CFP; nonmydriatic fundus photograph; camera: NIDEK AFC-230; 45° FOV: 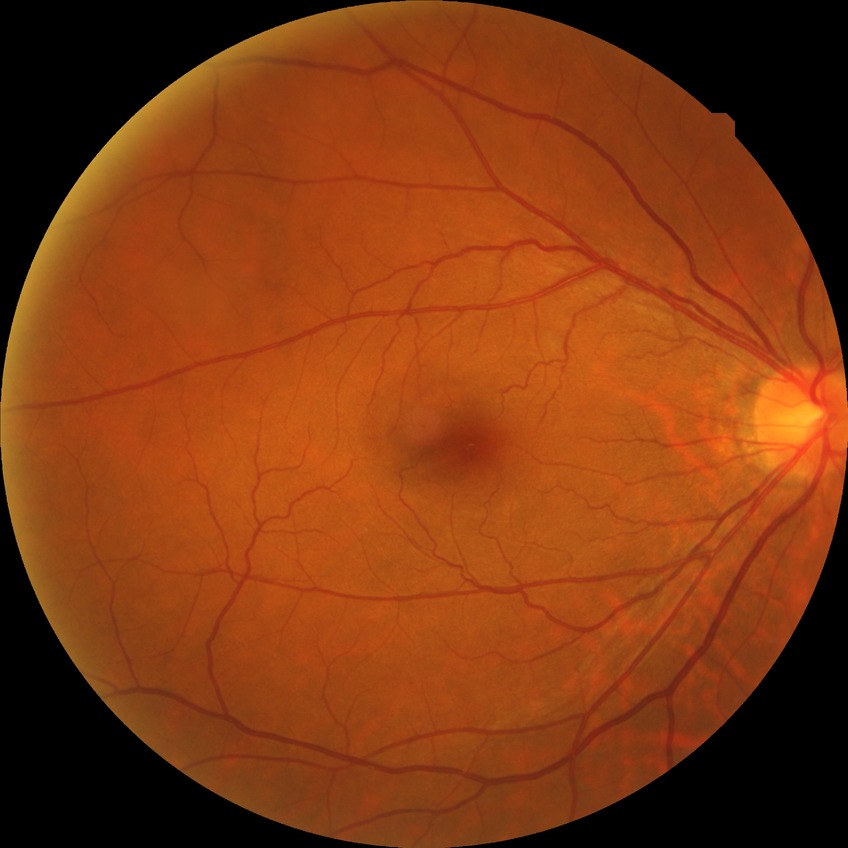

diabetic retinopathy (DR)@NDR (no diabetic retinopathy).